Optic nerve head photograph — 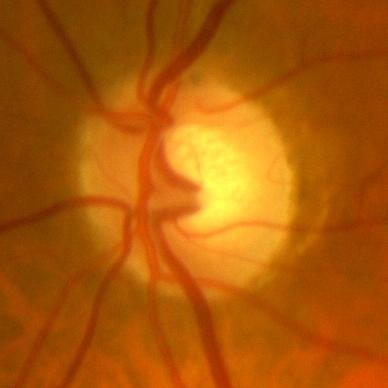
Optic disc appearance consistent with no signs of glaucoma.